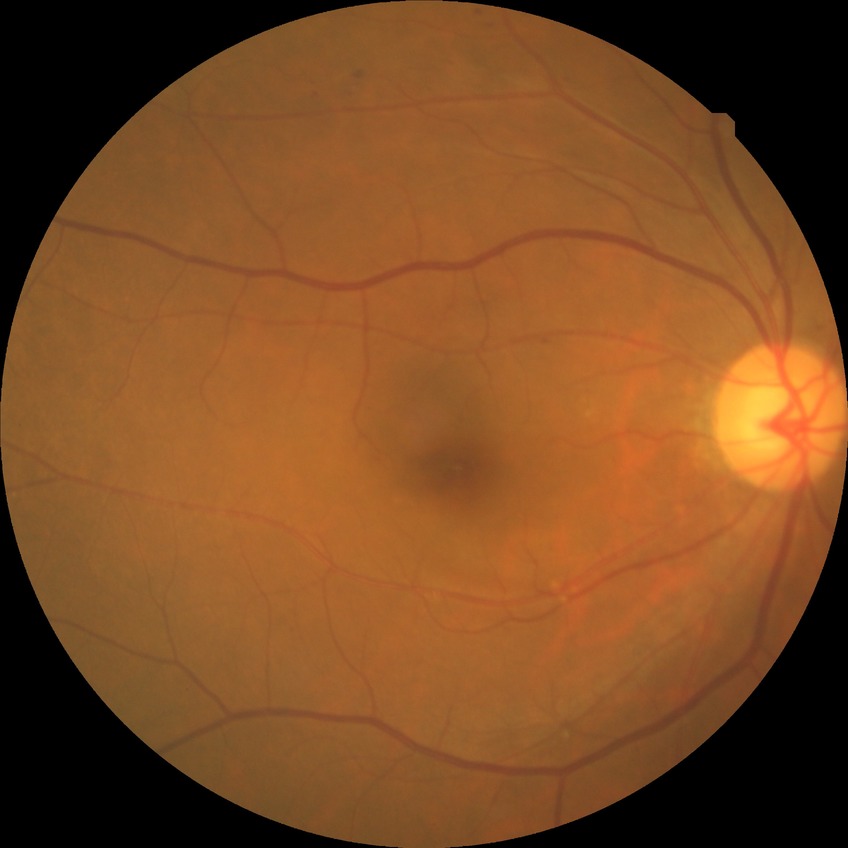

Diabetic retinopathy (DR): simple diabetic retinopathy (SDR).
Disease class: non-proliferative diabetic retinopathy.